45 degree fundus photograph, fundus photo, nonmydriatic, 848x848, NIDEK AFC-230 fundus camera — 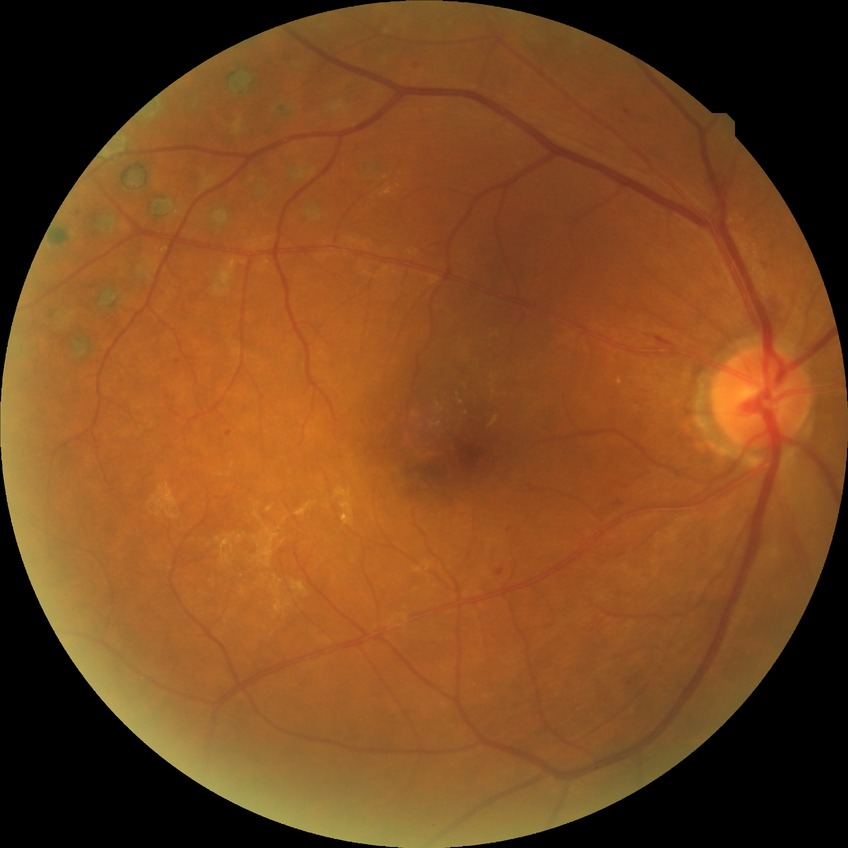

Diabetic retinopathy (DR): PDR (proliferative diabetic retinopathy).